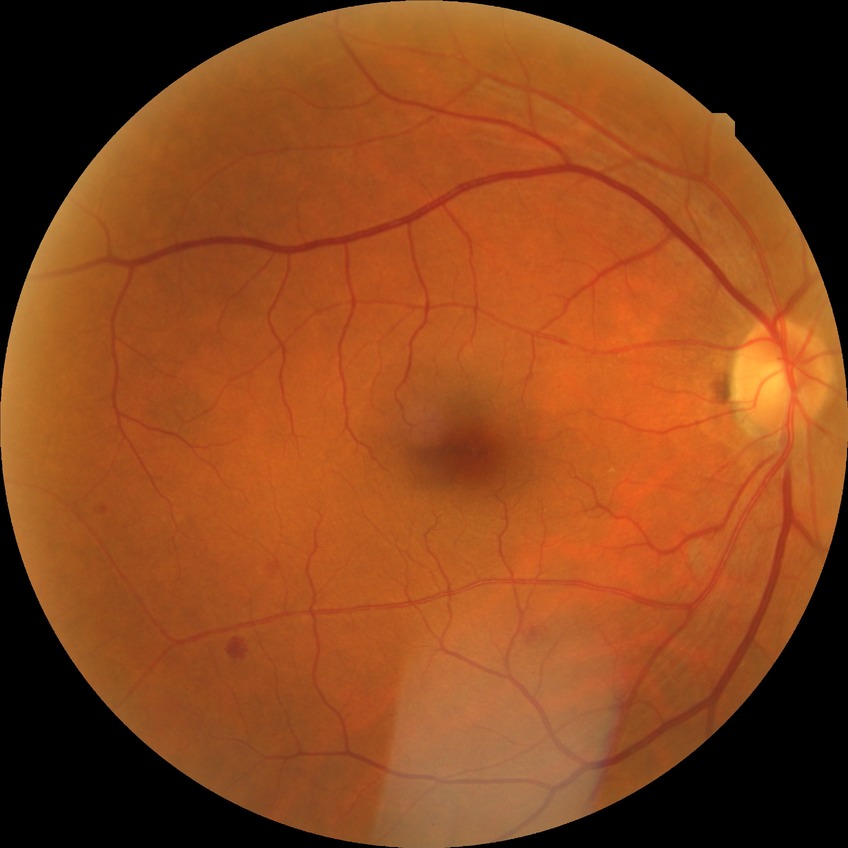

Diabetic retinopathy (DR) is SDR (simple diabetic retinopathy).